FOV: 45 degrees, DR severity per modified Davis staging, camera: NIDEK AFC-230
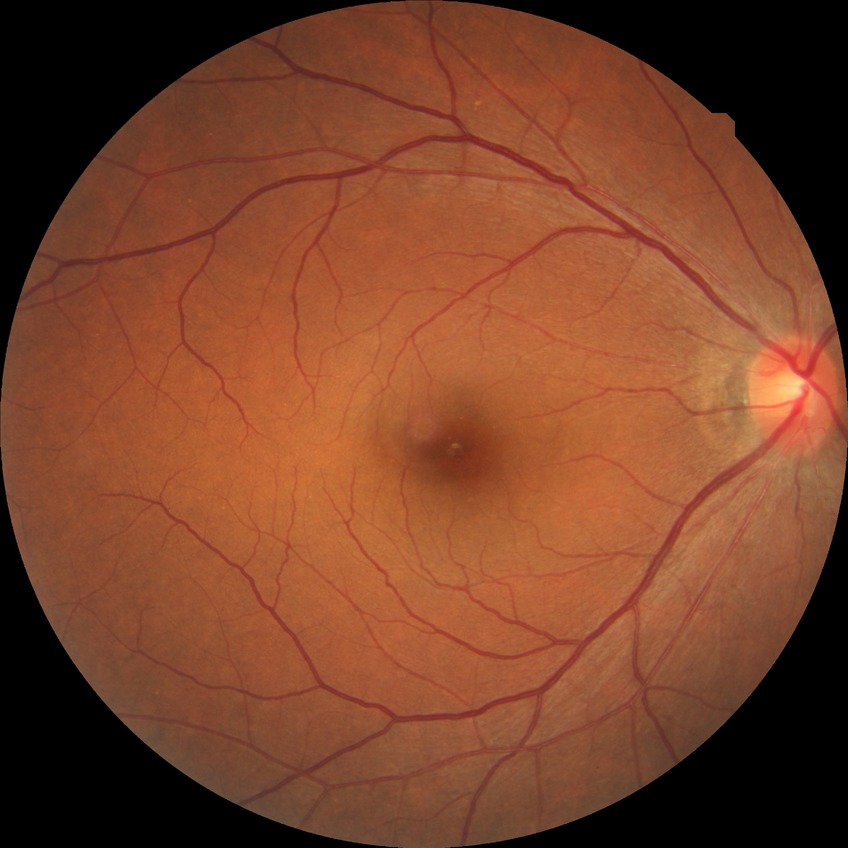 DR stage: NDR.